NIDEK AFC-230 fundus camera · modified Davis classification
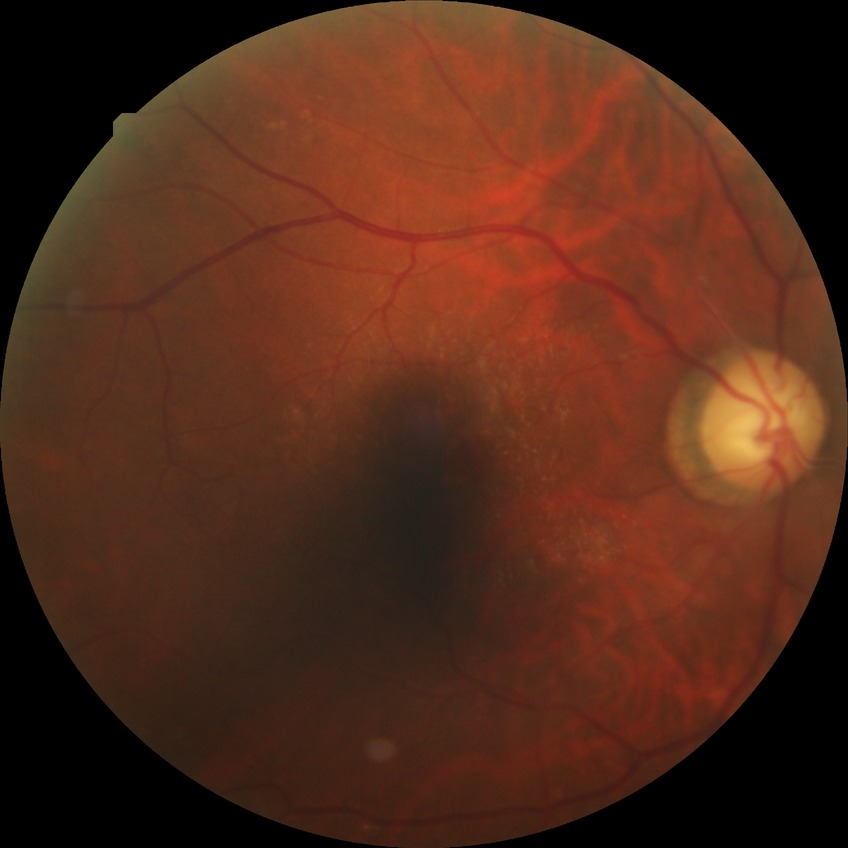 No signs of diabetic retinopathy. DR: NDR.